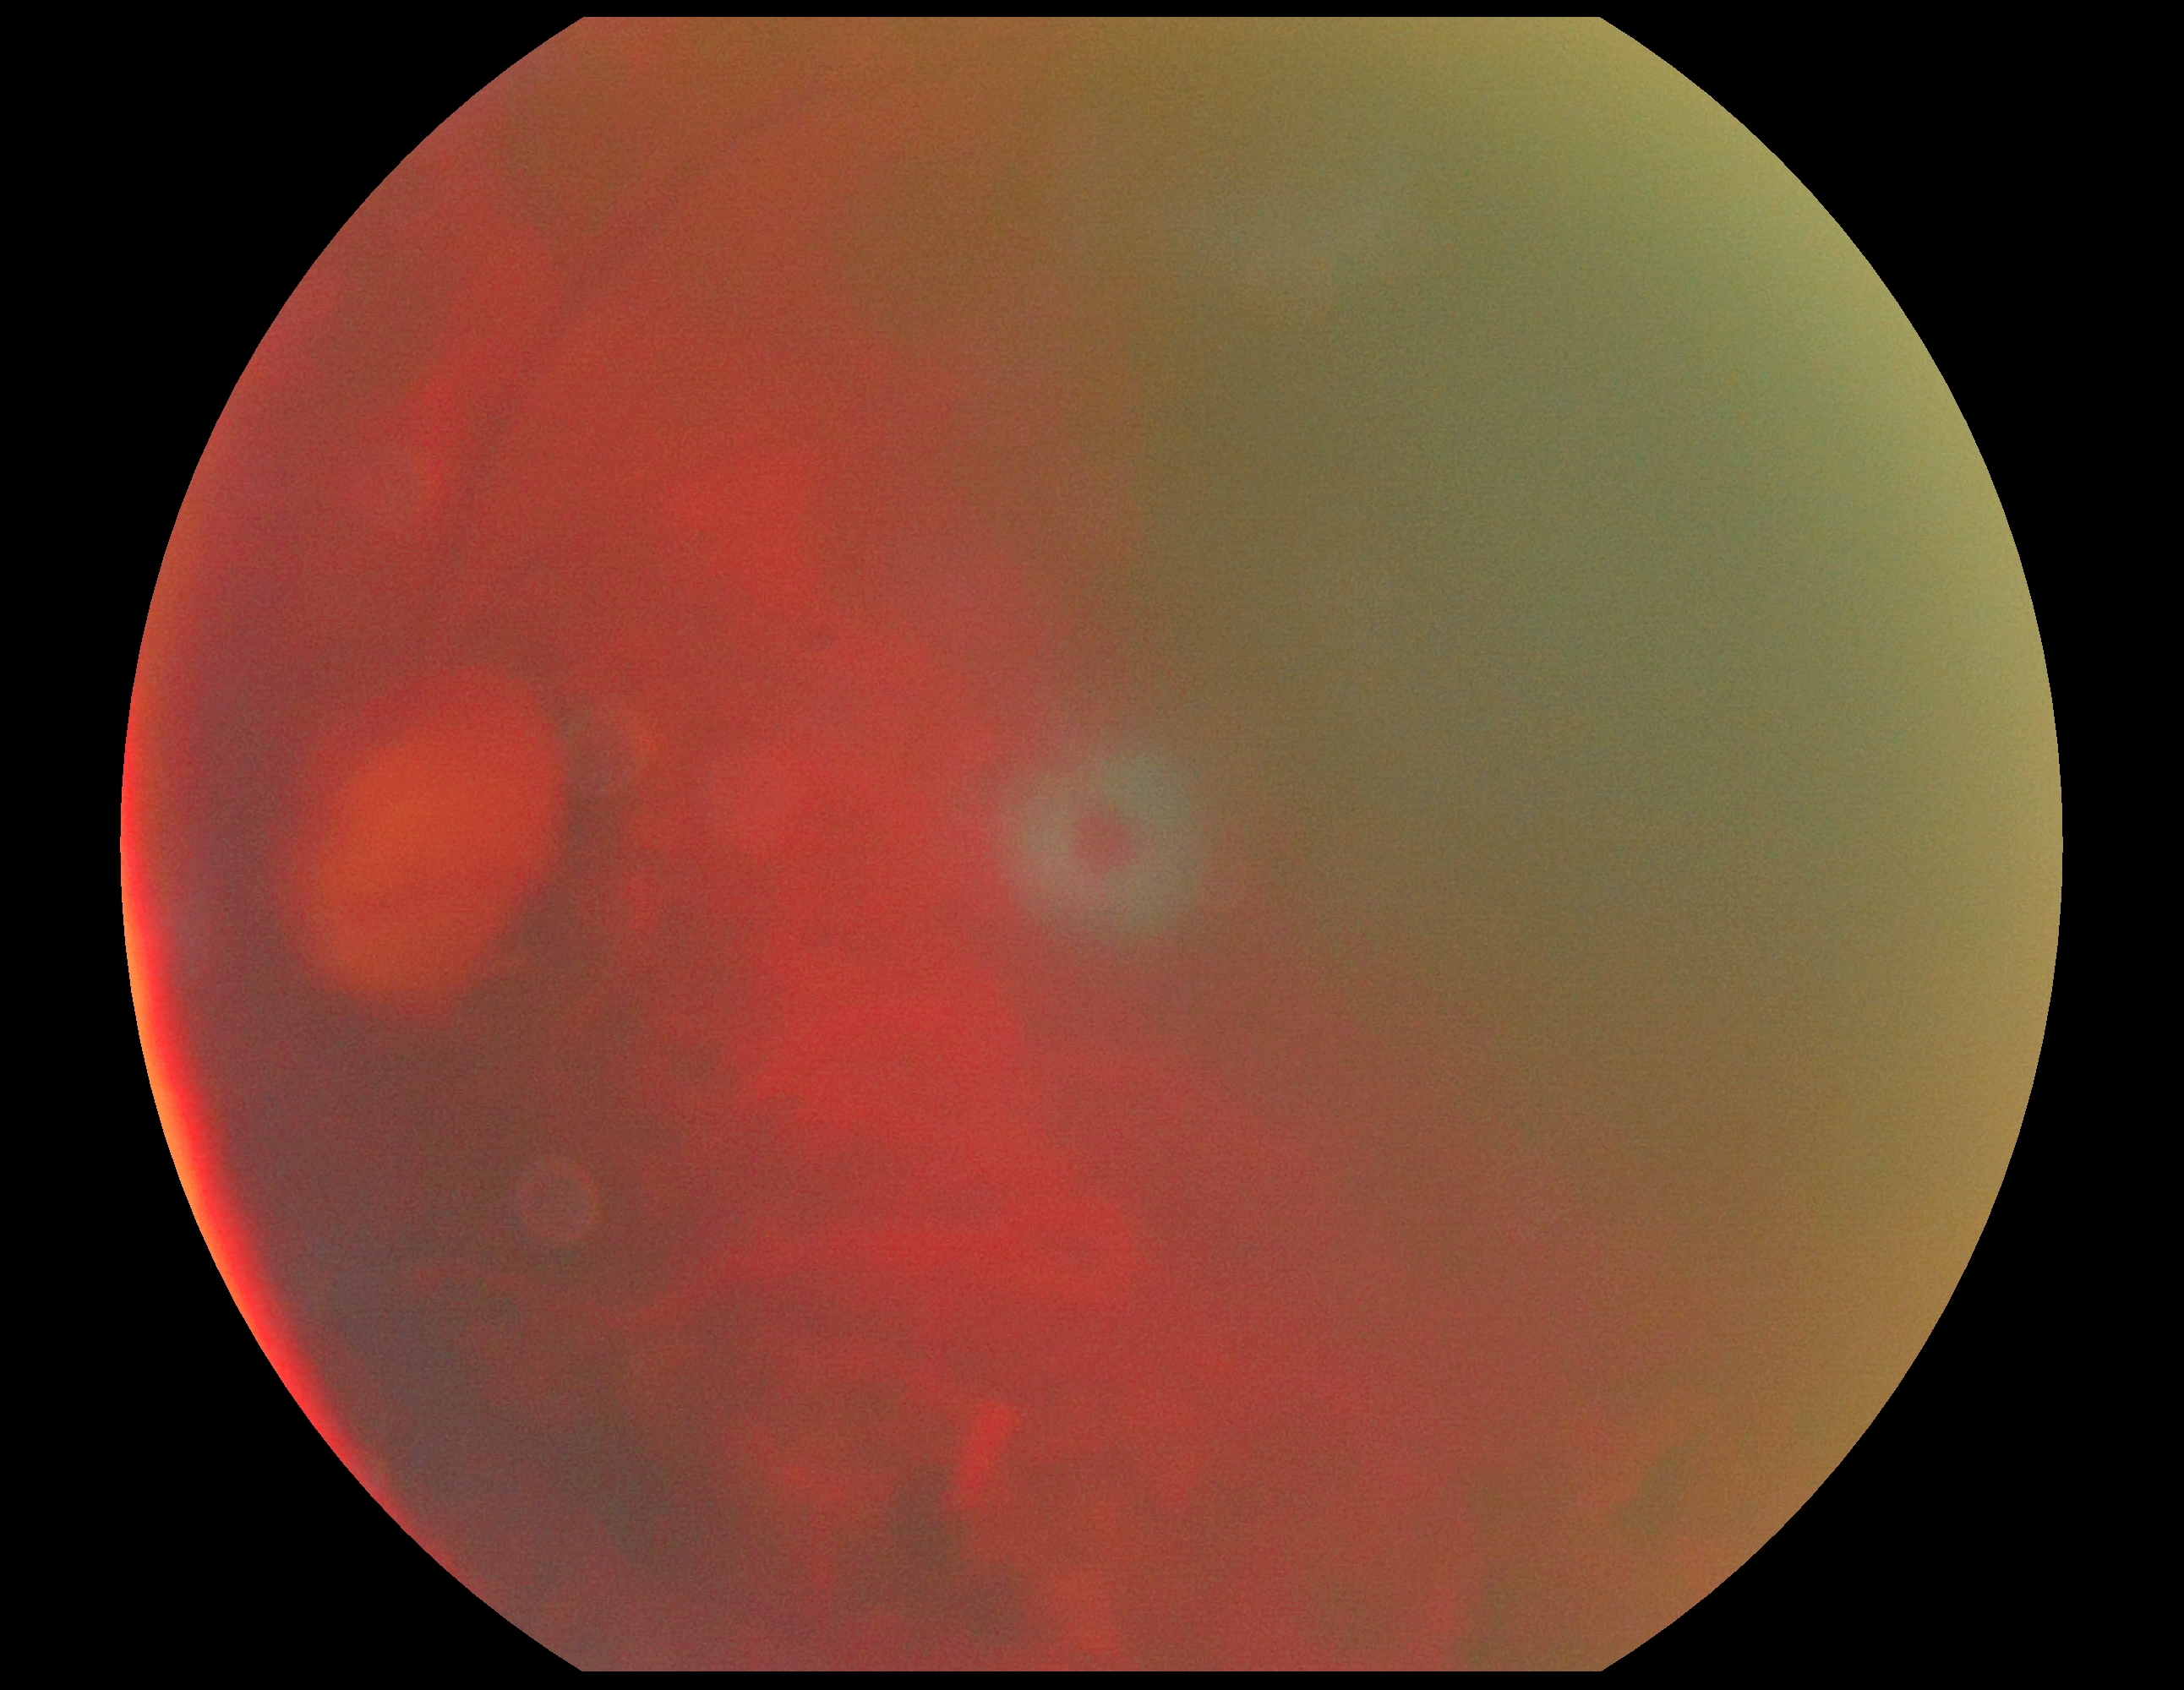 Retinopathy grade is ungradable.
Quality too poor to assess for DR.